Pediatric wide-field fundus photograph: 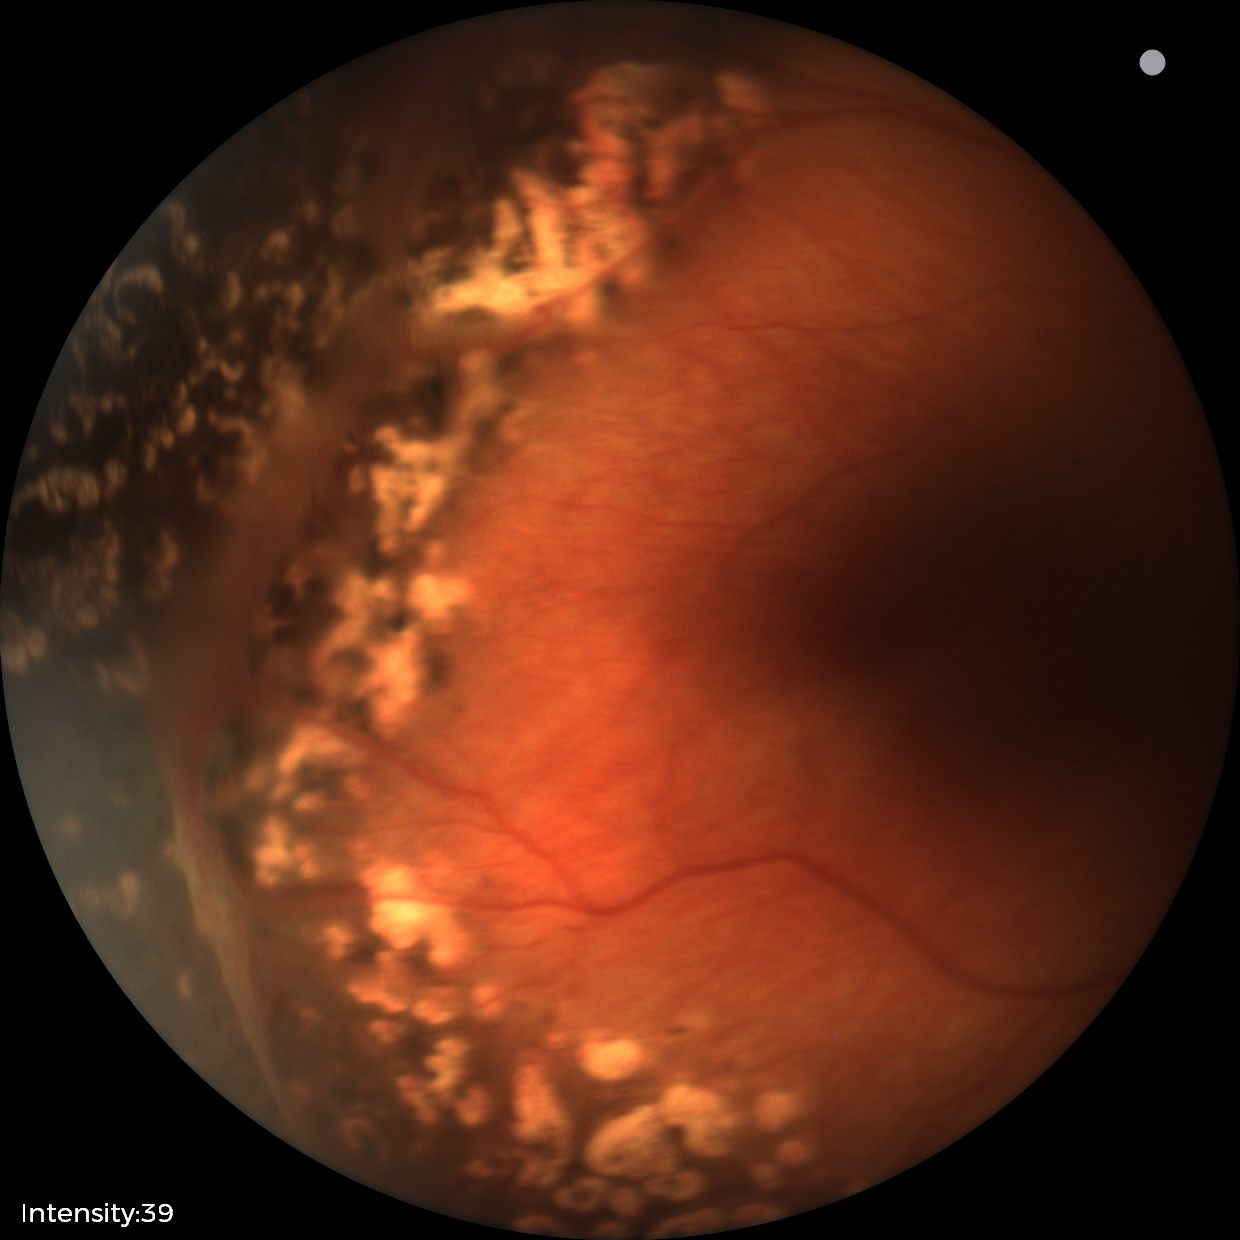

Series diagnosed as status post ROP — retinal appearance after treated retinopathy of prematurity.